45° FOV — 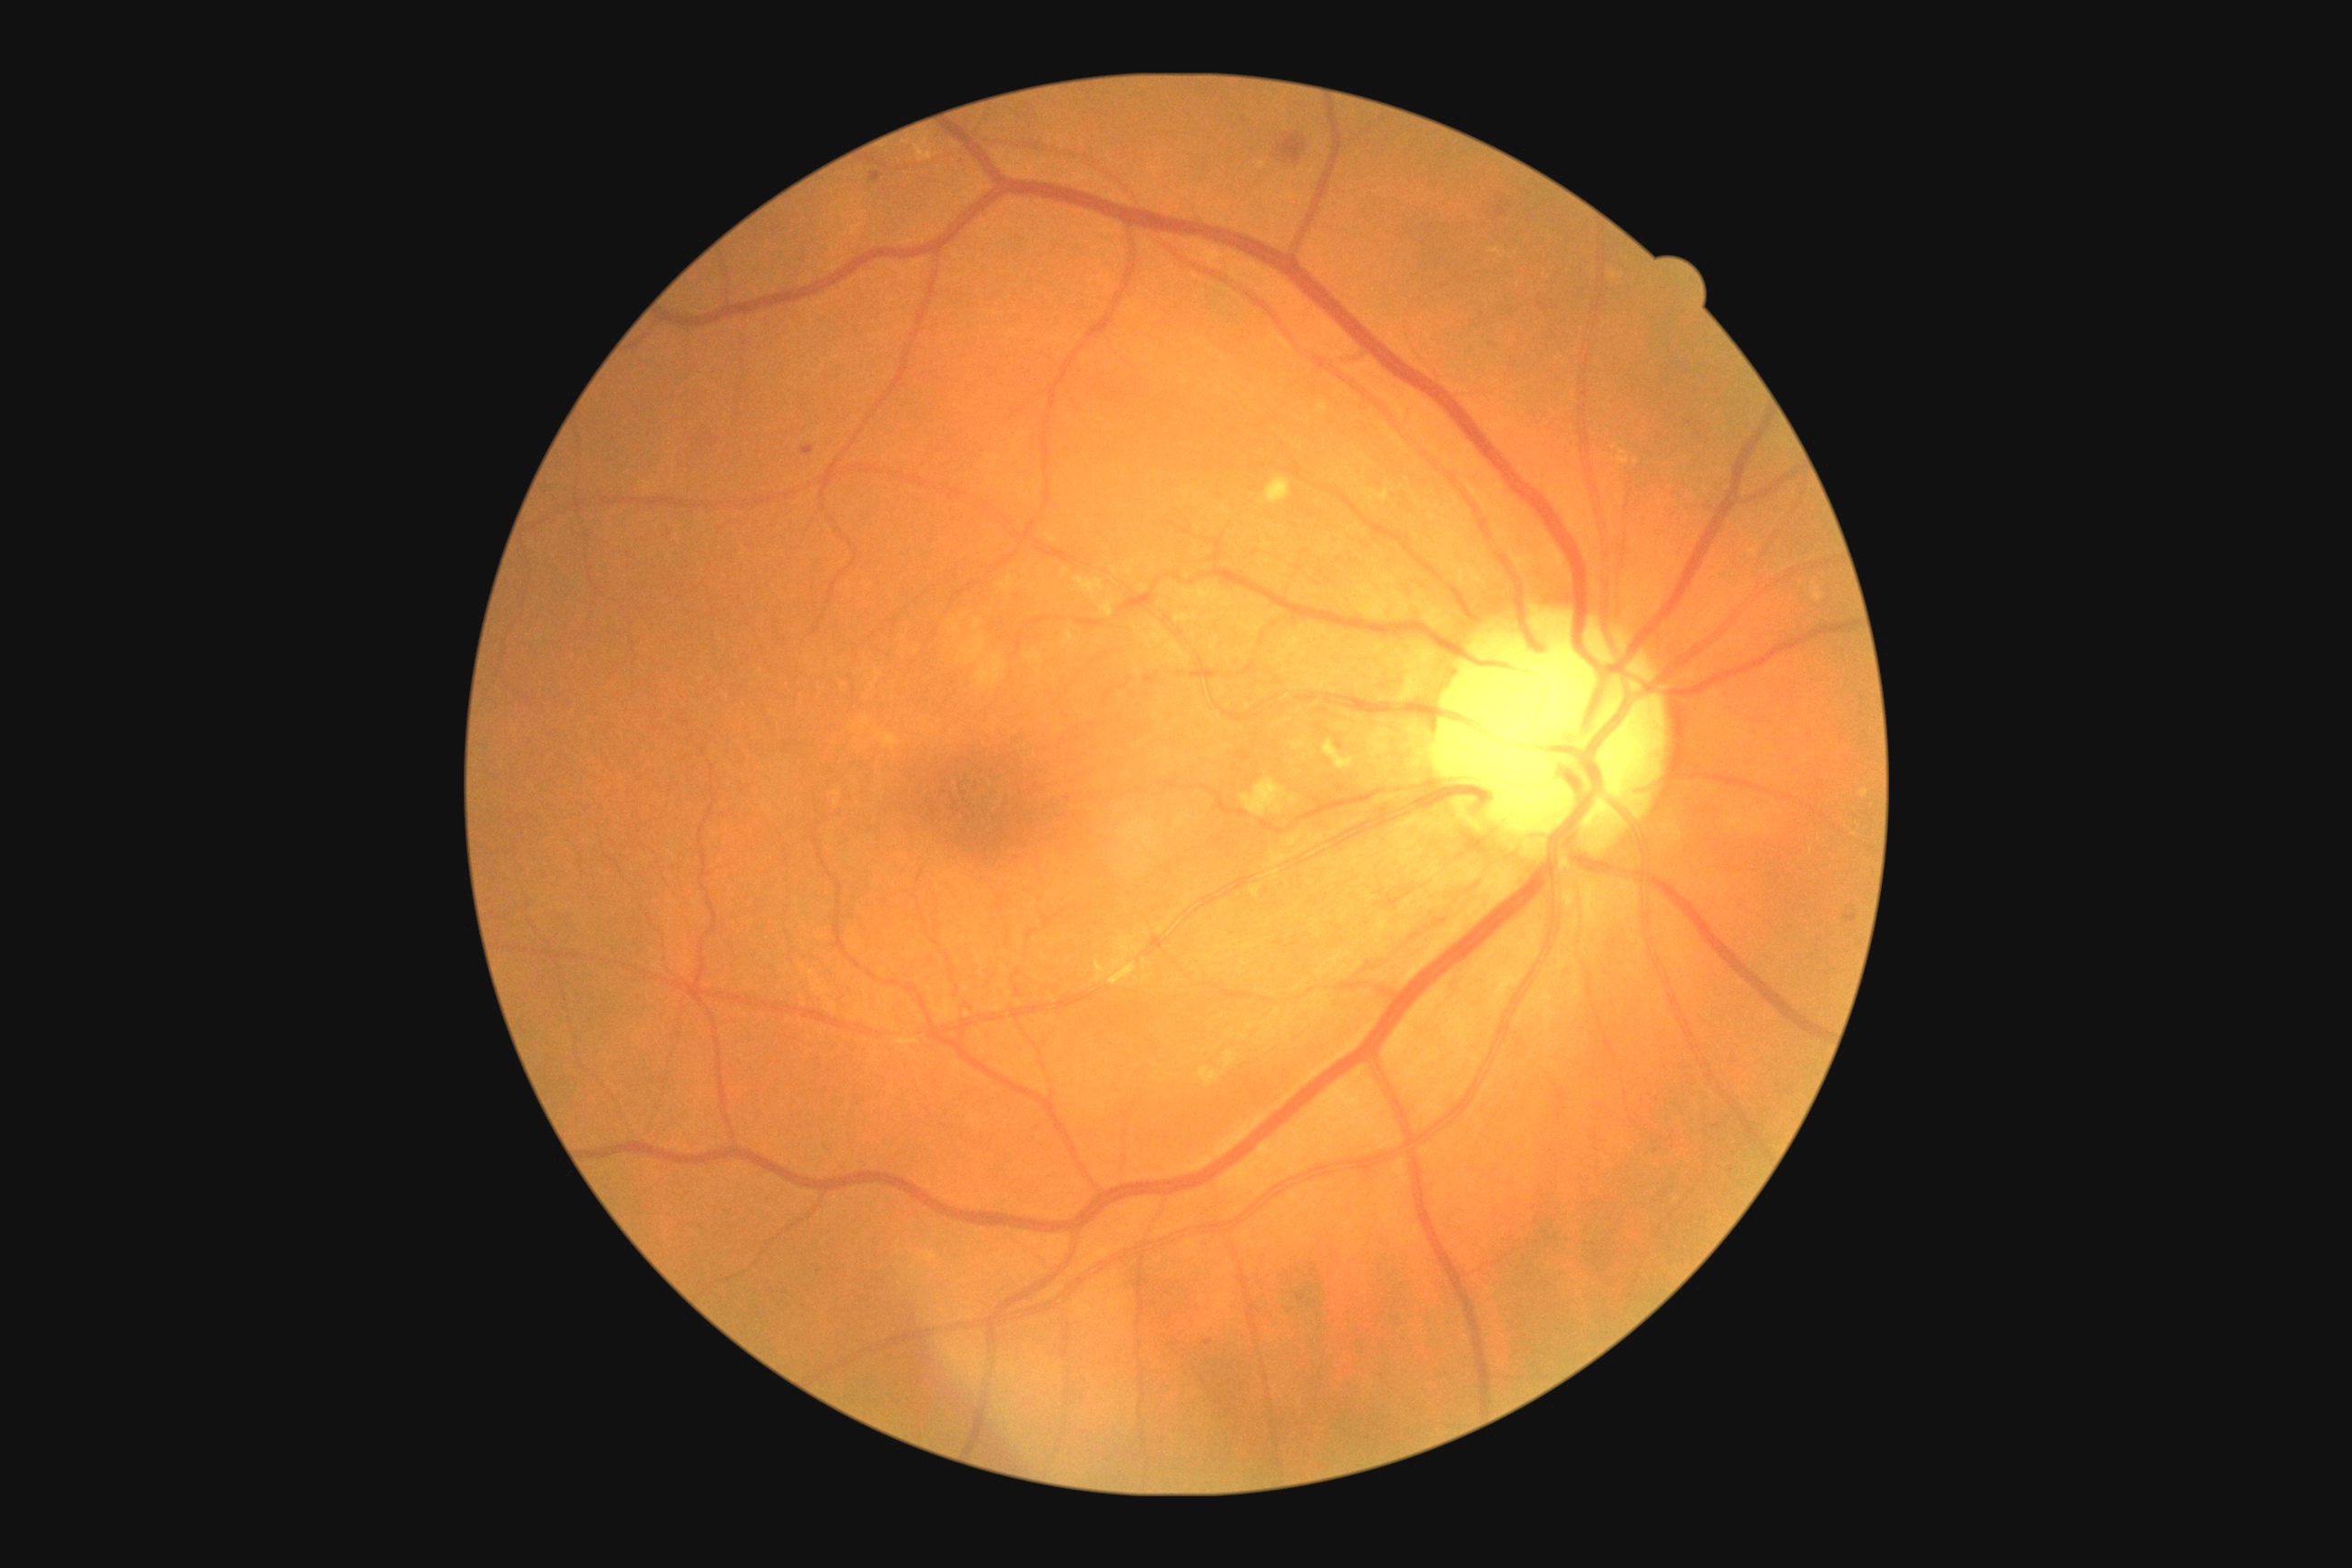 Diabetic retinopathy (DR) is moderate non-proliferative diabetic retinopathy (grade 2) — more than just microaneurysms but less than severe NPDR.
No soft exudates (SEs) identified.
Hard exudates (EXs) at bbox=[1075, 576, 1104, 600], bbox=[1101, 602, 1113, 618], bbox=[1291, 741, 1308, 750], bbox=[1250, 887, 1260, 897], bbox=[1242, 778, 1288, 818], bbox=[1260, 476, 1291, 505], bbox=[1289, 796, 1297, 805], bbox=[1199, 1066, 1224, 1086], bbox=[1324, 740, 1355, 770], bbox=[876, 730, 899, 749], bbox=[1095, 961, 1104, 974], bbox=[1220, 1052, 1237, 1068].
Smaller EXs around <pt>1066,571</pt>.
Microaneurysms (MAs) at bbox=[1206, 1338, 1211, 1346], bbox=[1498, 206, 1505, 217].
Smaller MAs around <pt>1301,1300</pt>, <pt>1315,1269</pt>.
Hemorrhages (HEs) at bbox=[870, 172, 881, 184], bbox=[801, 447, 814, 456], bbox=[1277, 135, 1306, 164], bbox=[1845, 910, 1857, 923].